Image size 2352x1568; fundus photo: 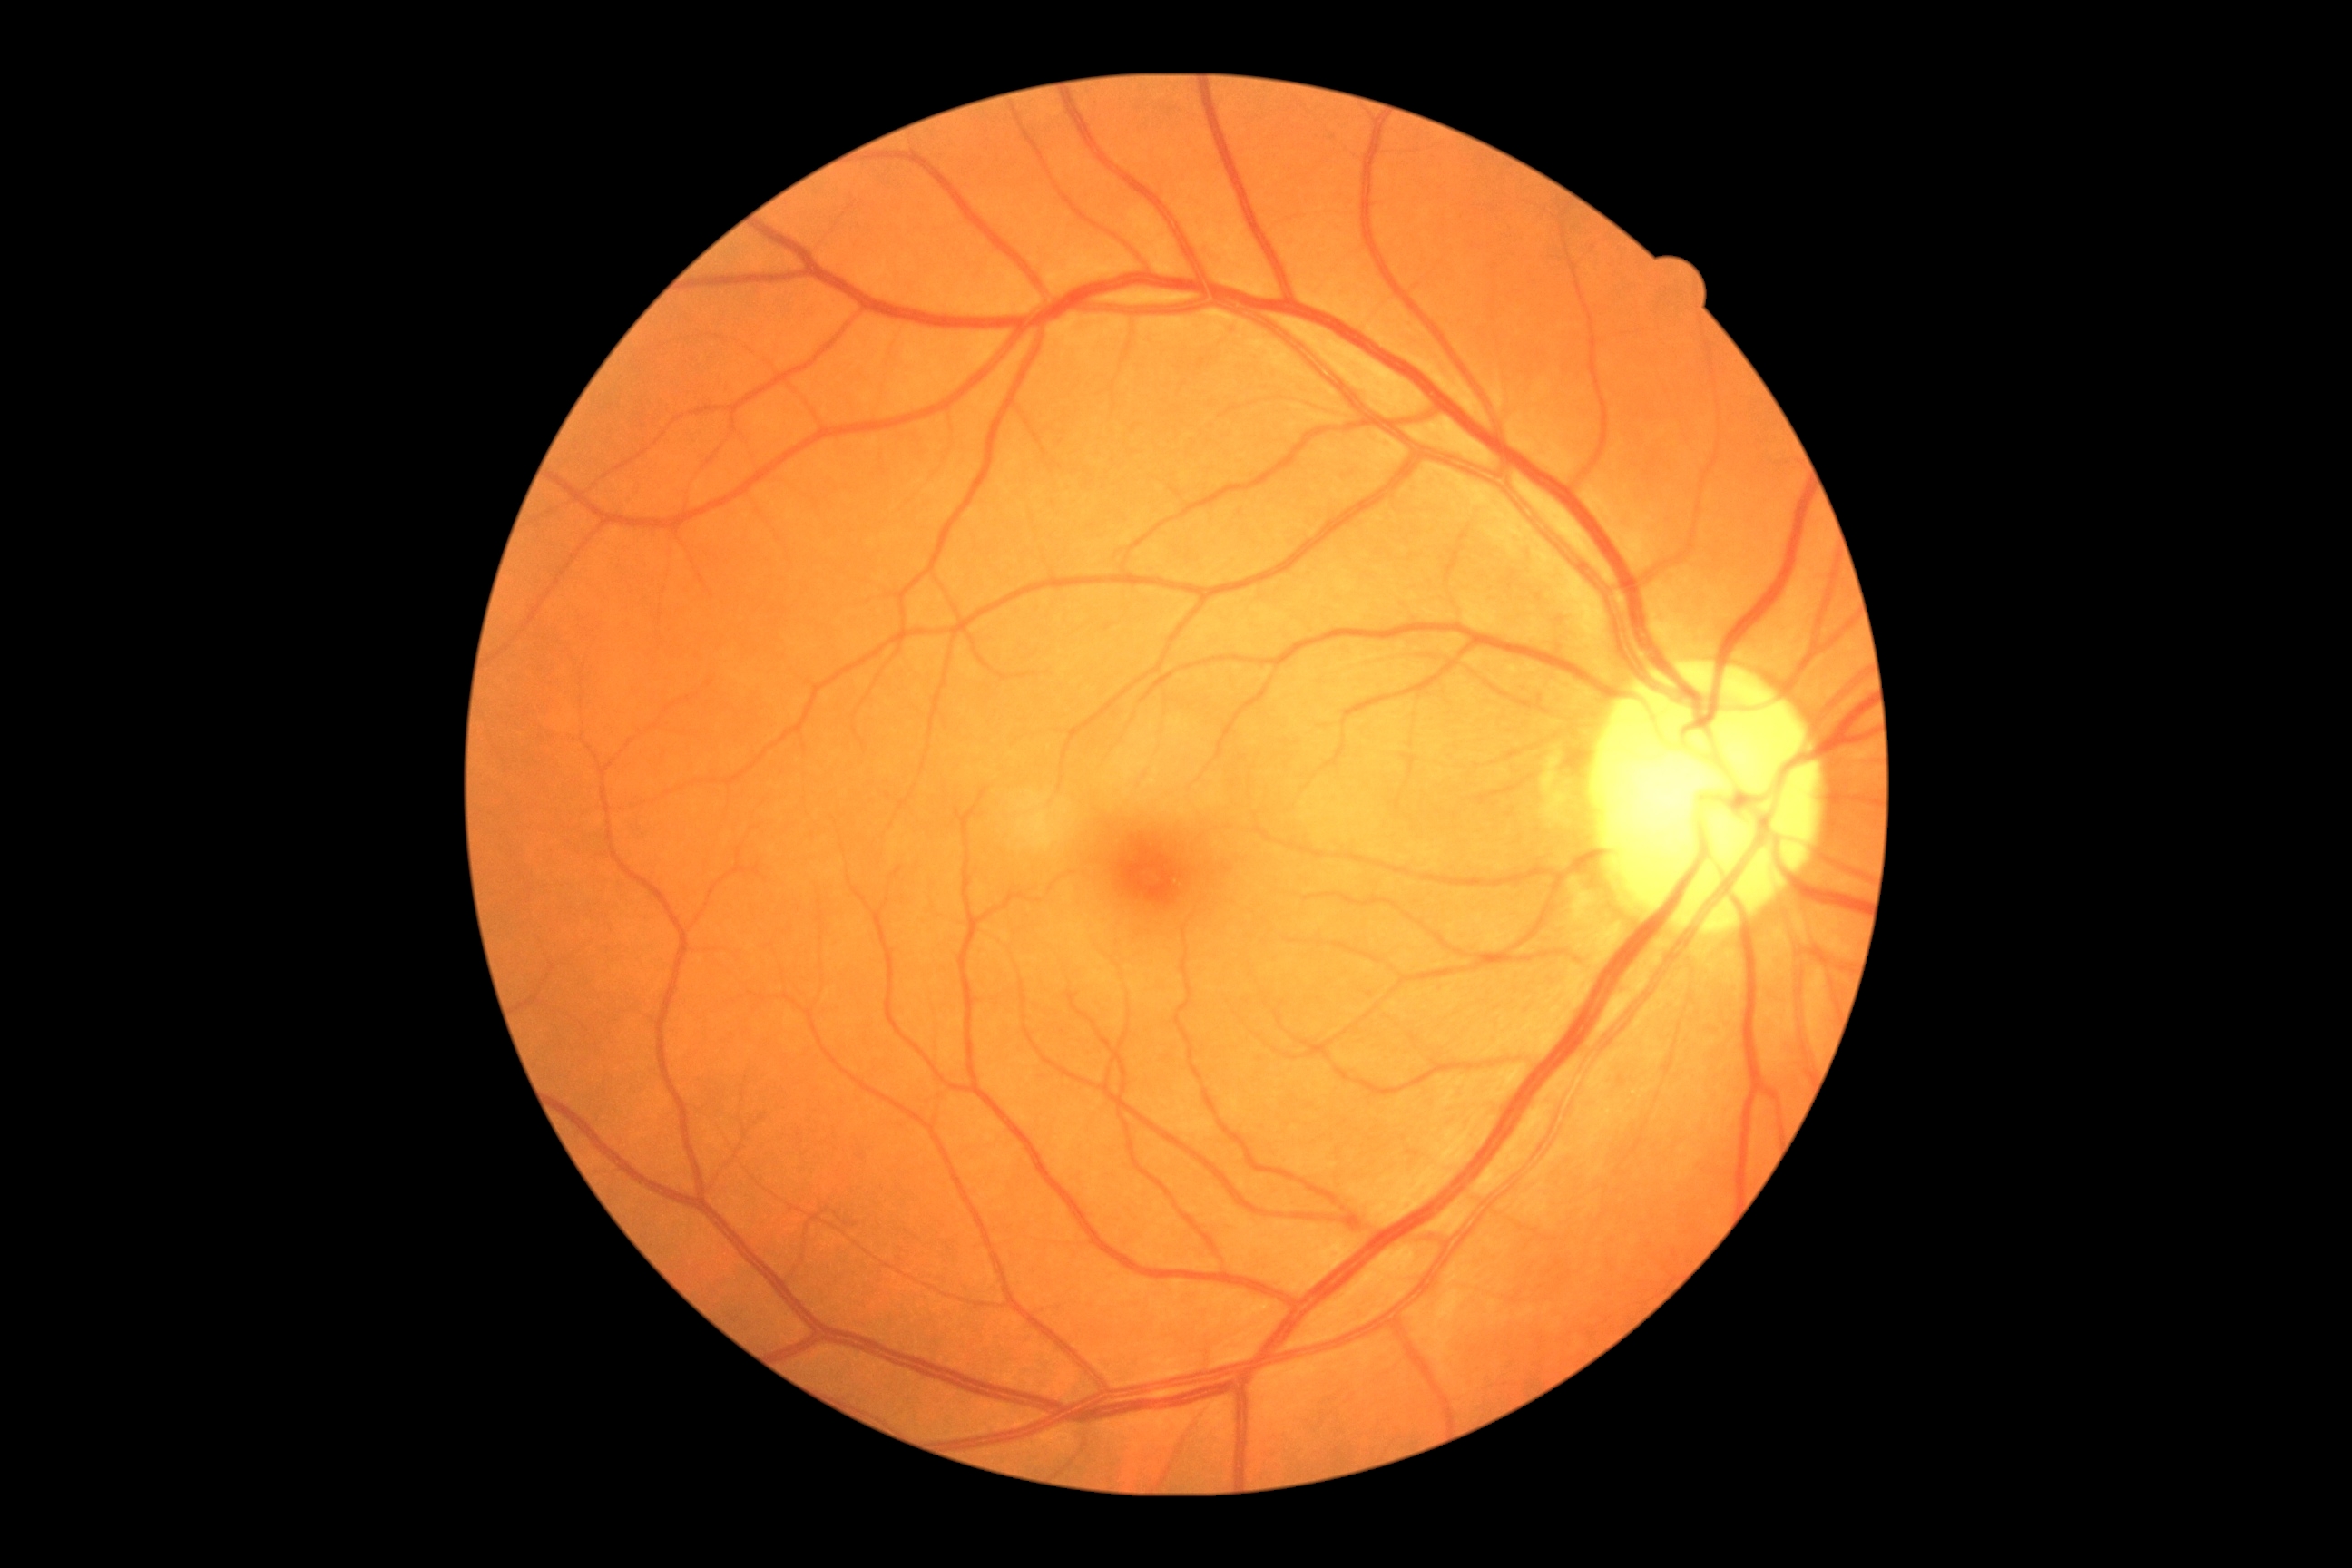

  dr_grade: no apparent diabetic retinopathy (grade 0) — no visible signs of diabetic retinopathy
  dr_impression: no signs of DR